Image size 848x848; 45° field of view; nonmydriatic
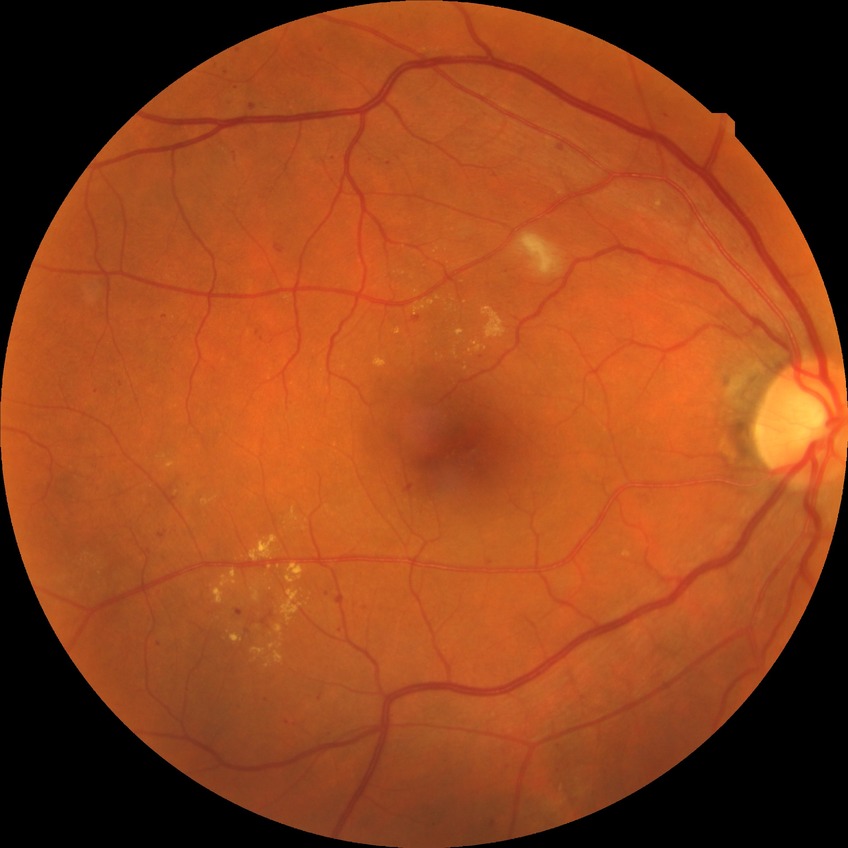 diabetic retinopathy (DR): simple diabetic retinopathy (SDR)
DR class: non-proliferative diabetic retinopathy